Acquired on the Clarity RetCam 3; wide-field fundus photograph from neonatal ROP screening; 640 by 480 pixels: 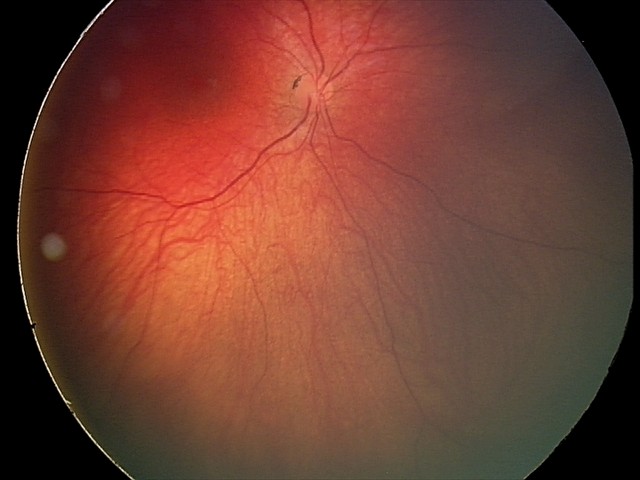
Assessment = retinal astrocytic hamartoma